50° FOV:
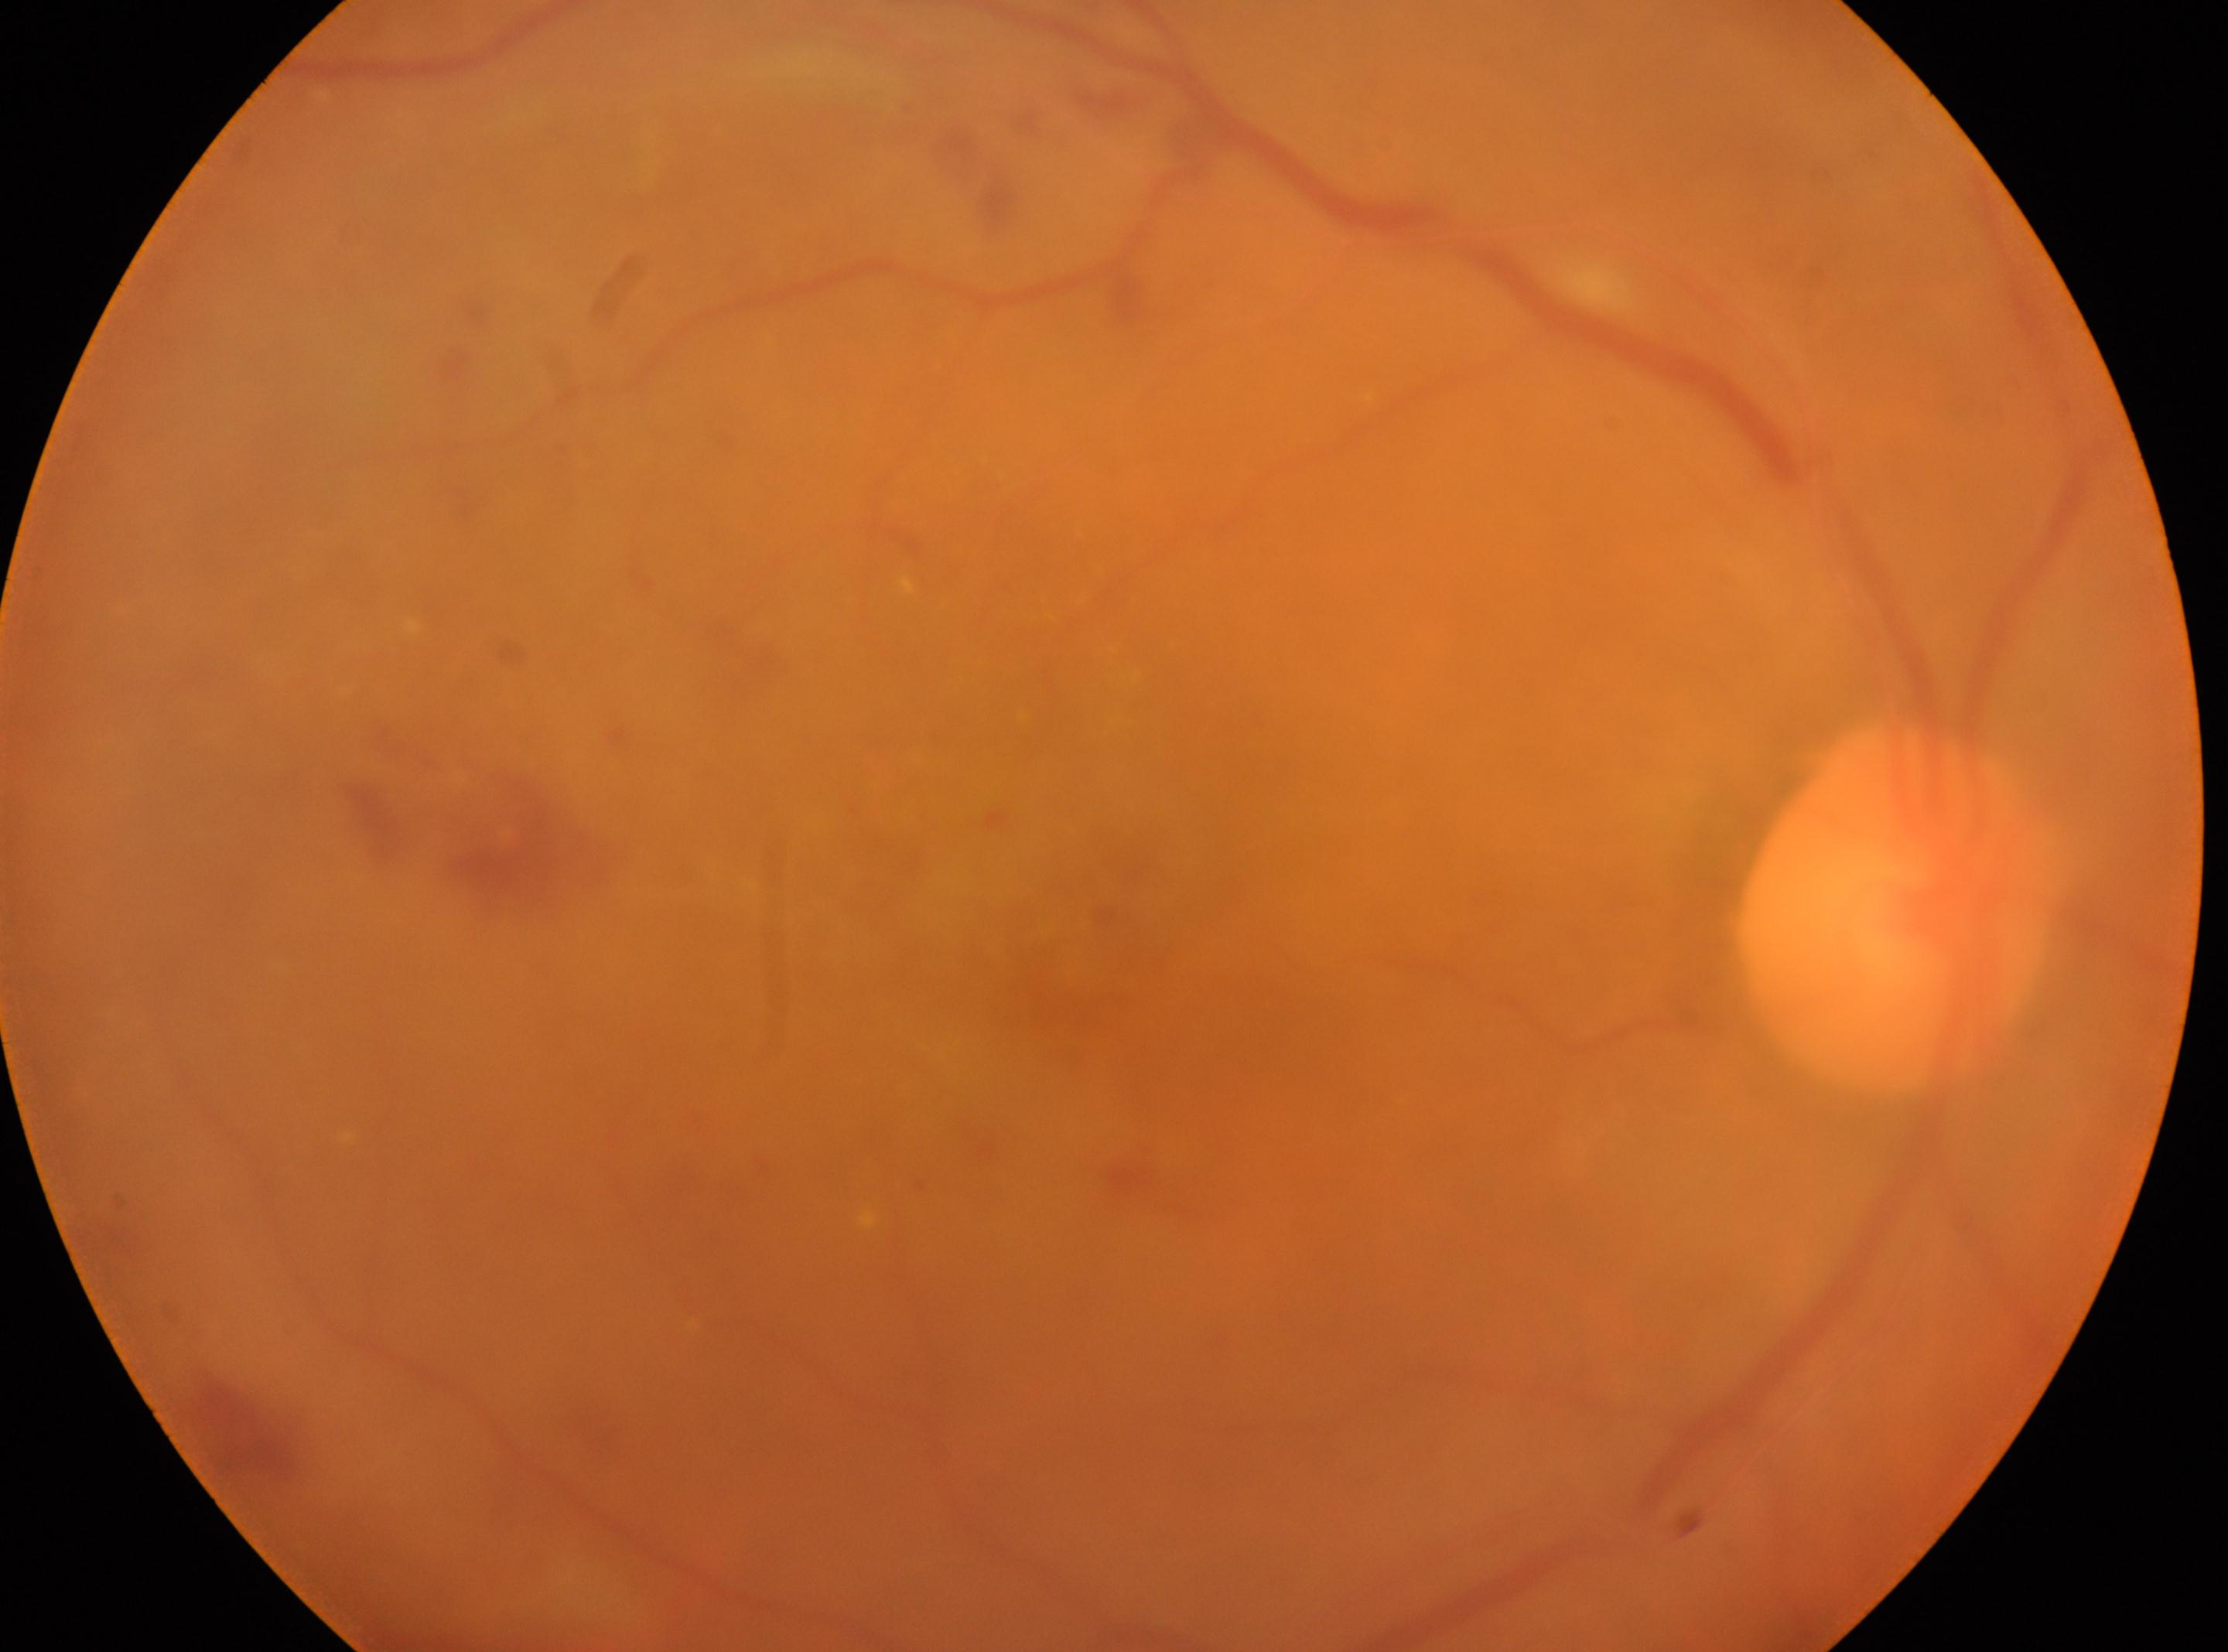

laterality: right | the optic disc: 1895, 906 | DR grade: 2 | the fovea: 1072, 967.